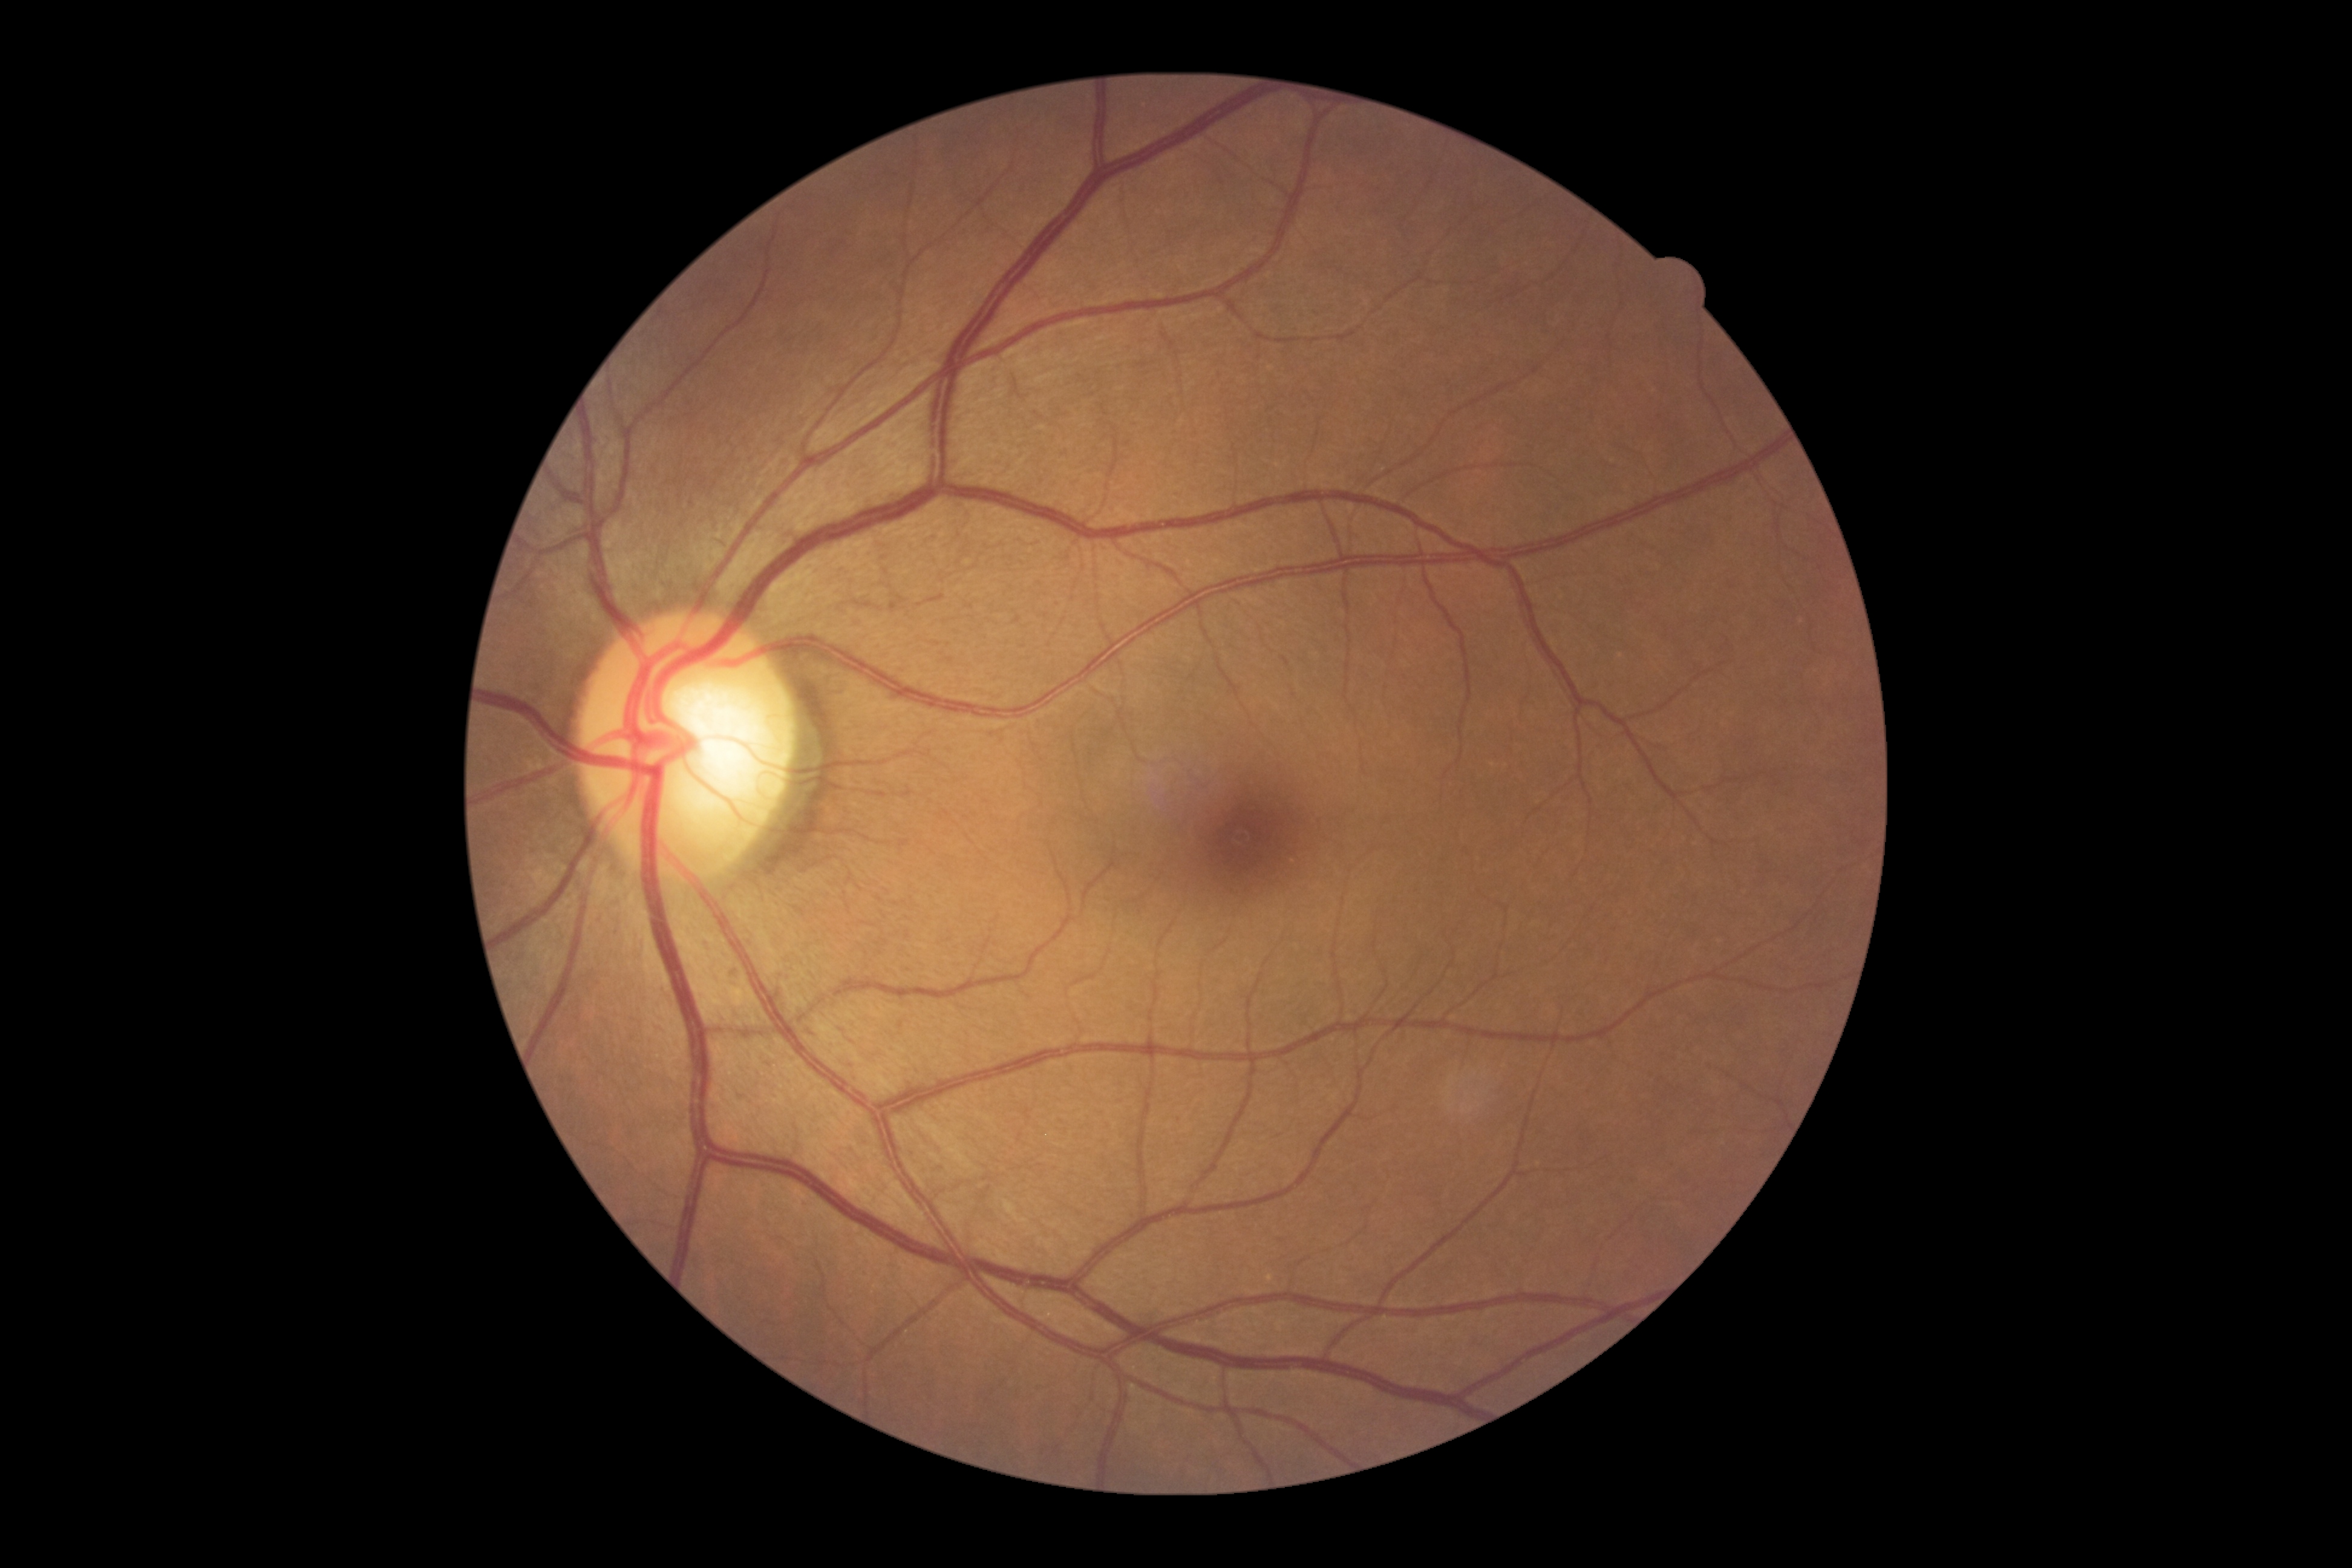
DR severity: 0/4.